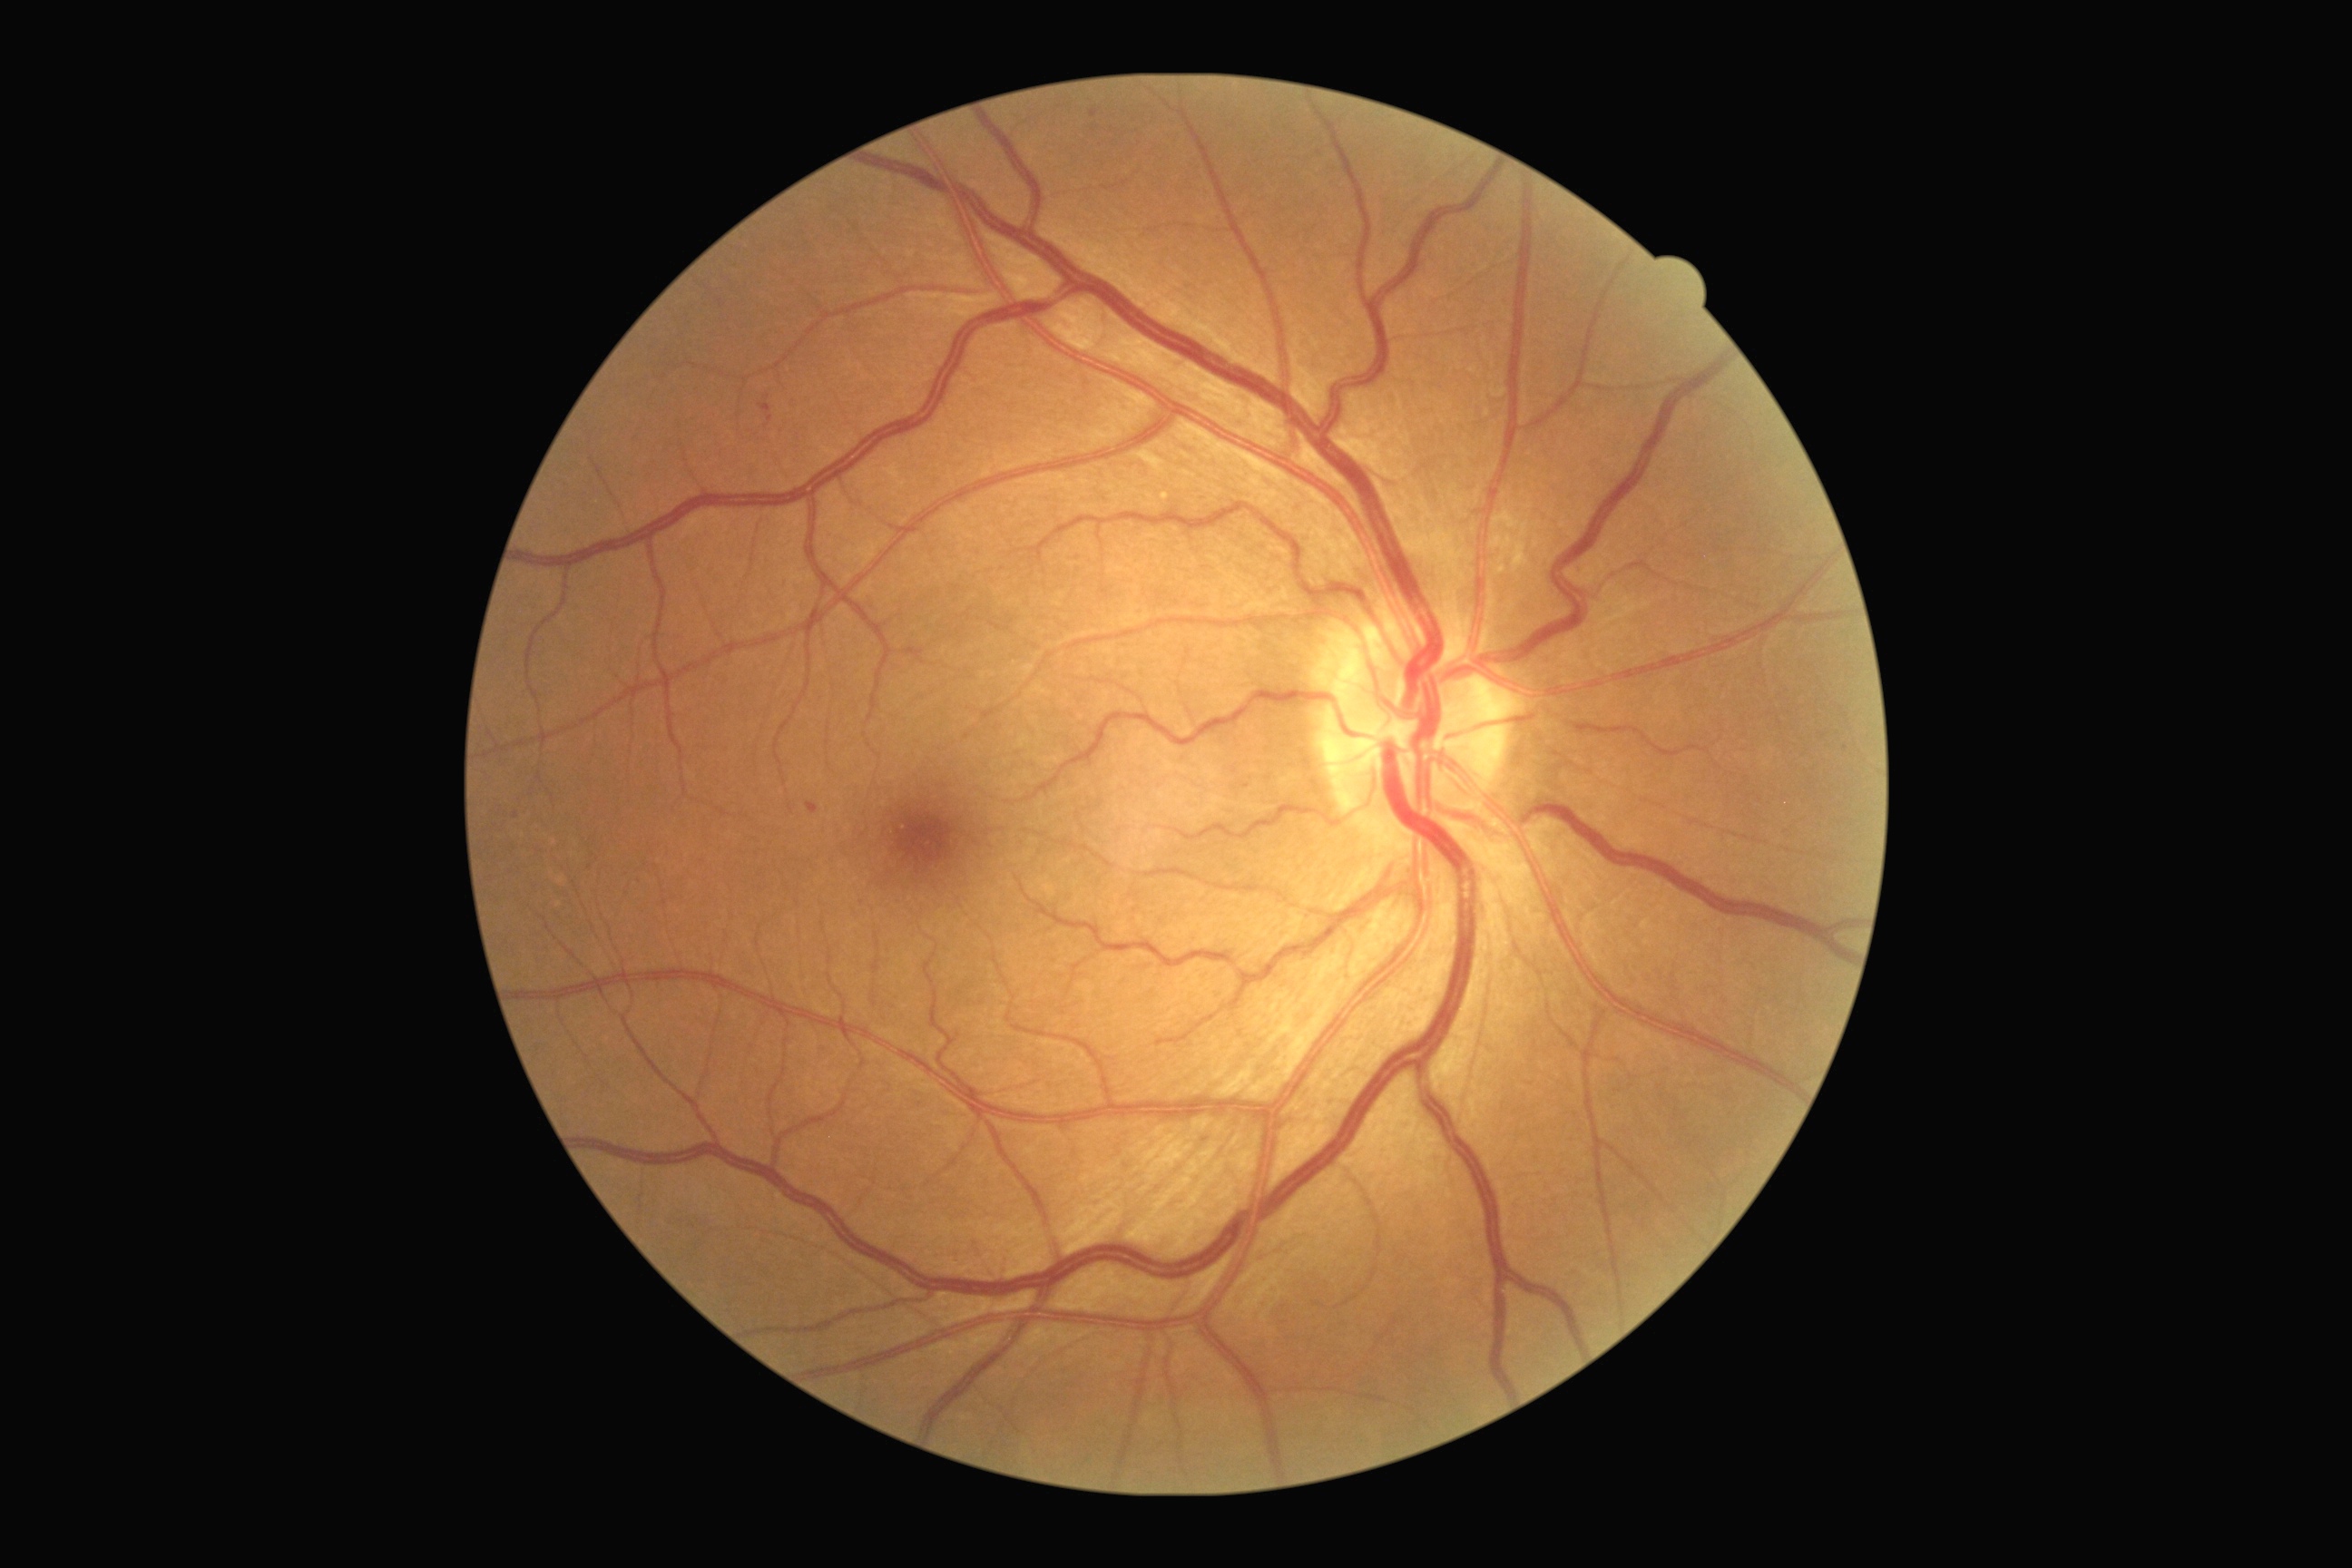 Diabetic retinopathy (DR) is mild non-proliferative diabetic retinopathy (grade 1); non-proliferative diabetic retinopathy
Detected lesions:
* hemorrhages (HEs): absent
* microaneurysms (MAs): <box>1090,110,1097,119</box>; <box>760,404,774,424</box>; <box>807,803,819,814</box>
* Small MAs near 515/815; 591/868; 638/881; 1845/748
* hard exudates (EXs): absent
* soft exudates (SEs): absent